Image size 2352x1568, 45° field of view.
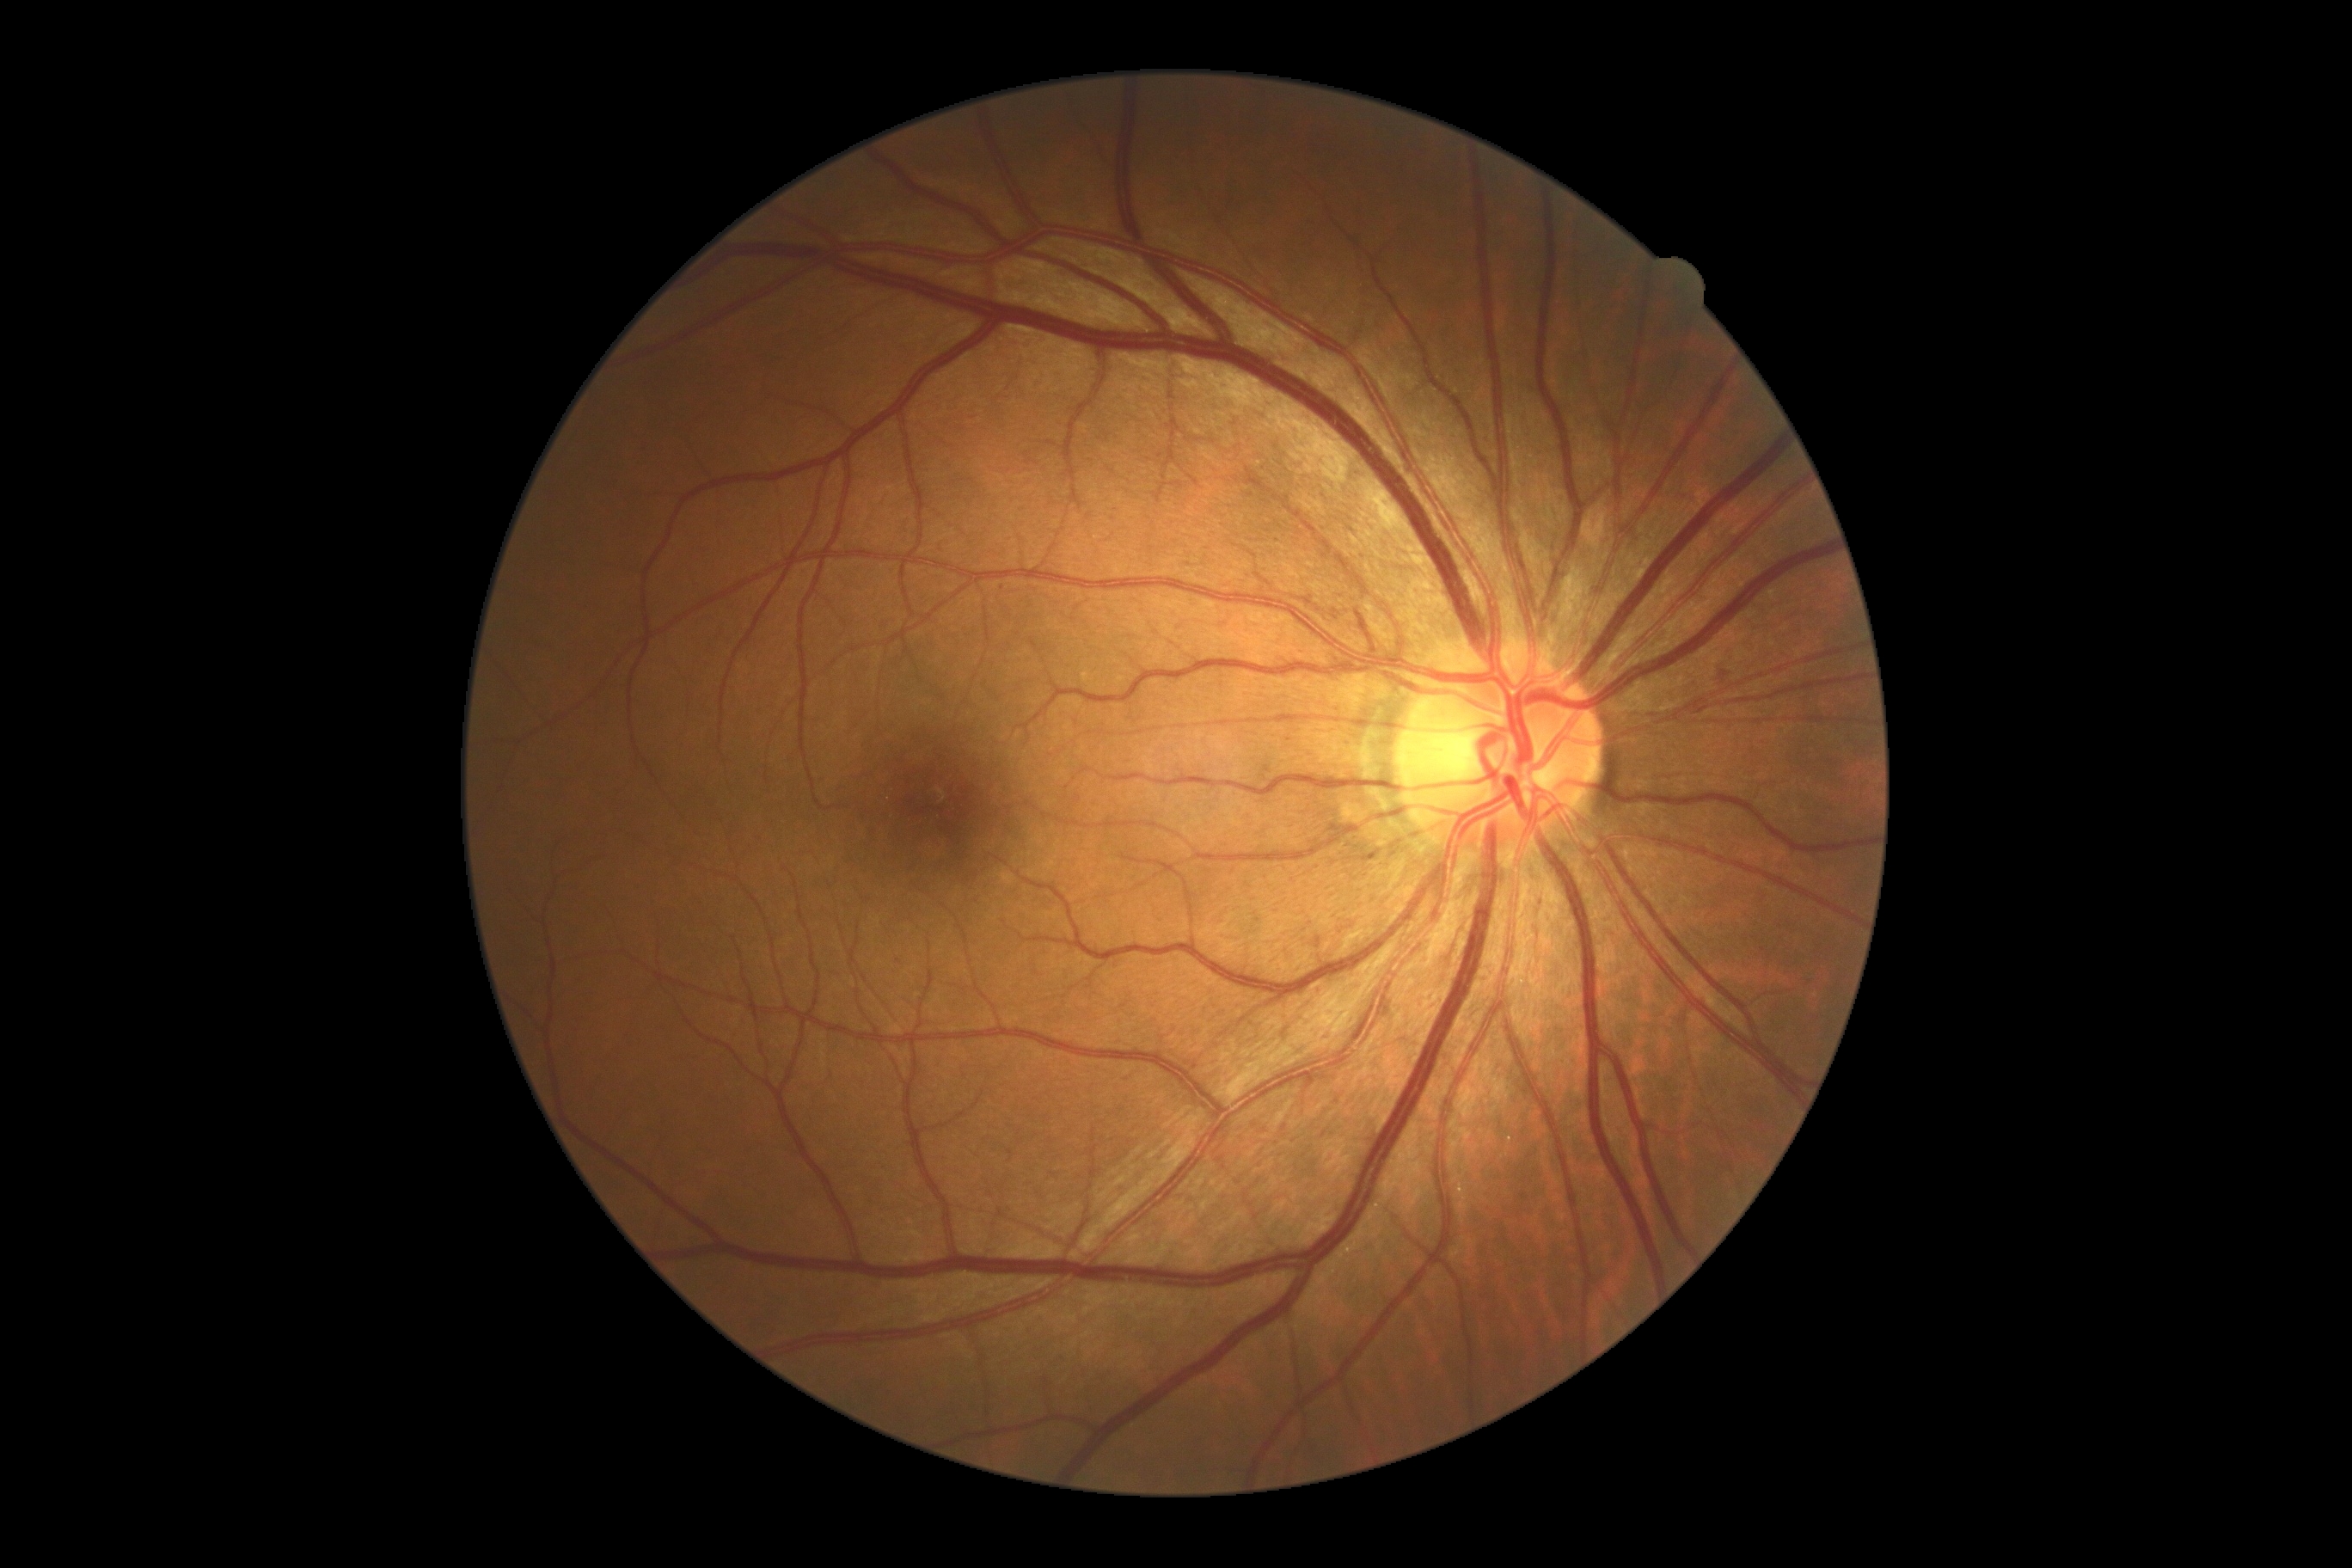 dr_grade: moderate non-proliferative diabetic retinopathy (2) — more than just microaneurysms but less than severe NPDR